45° field of view
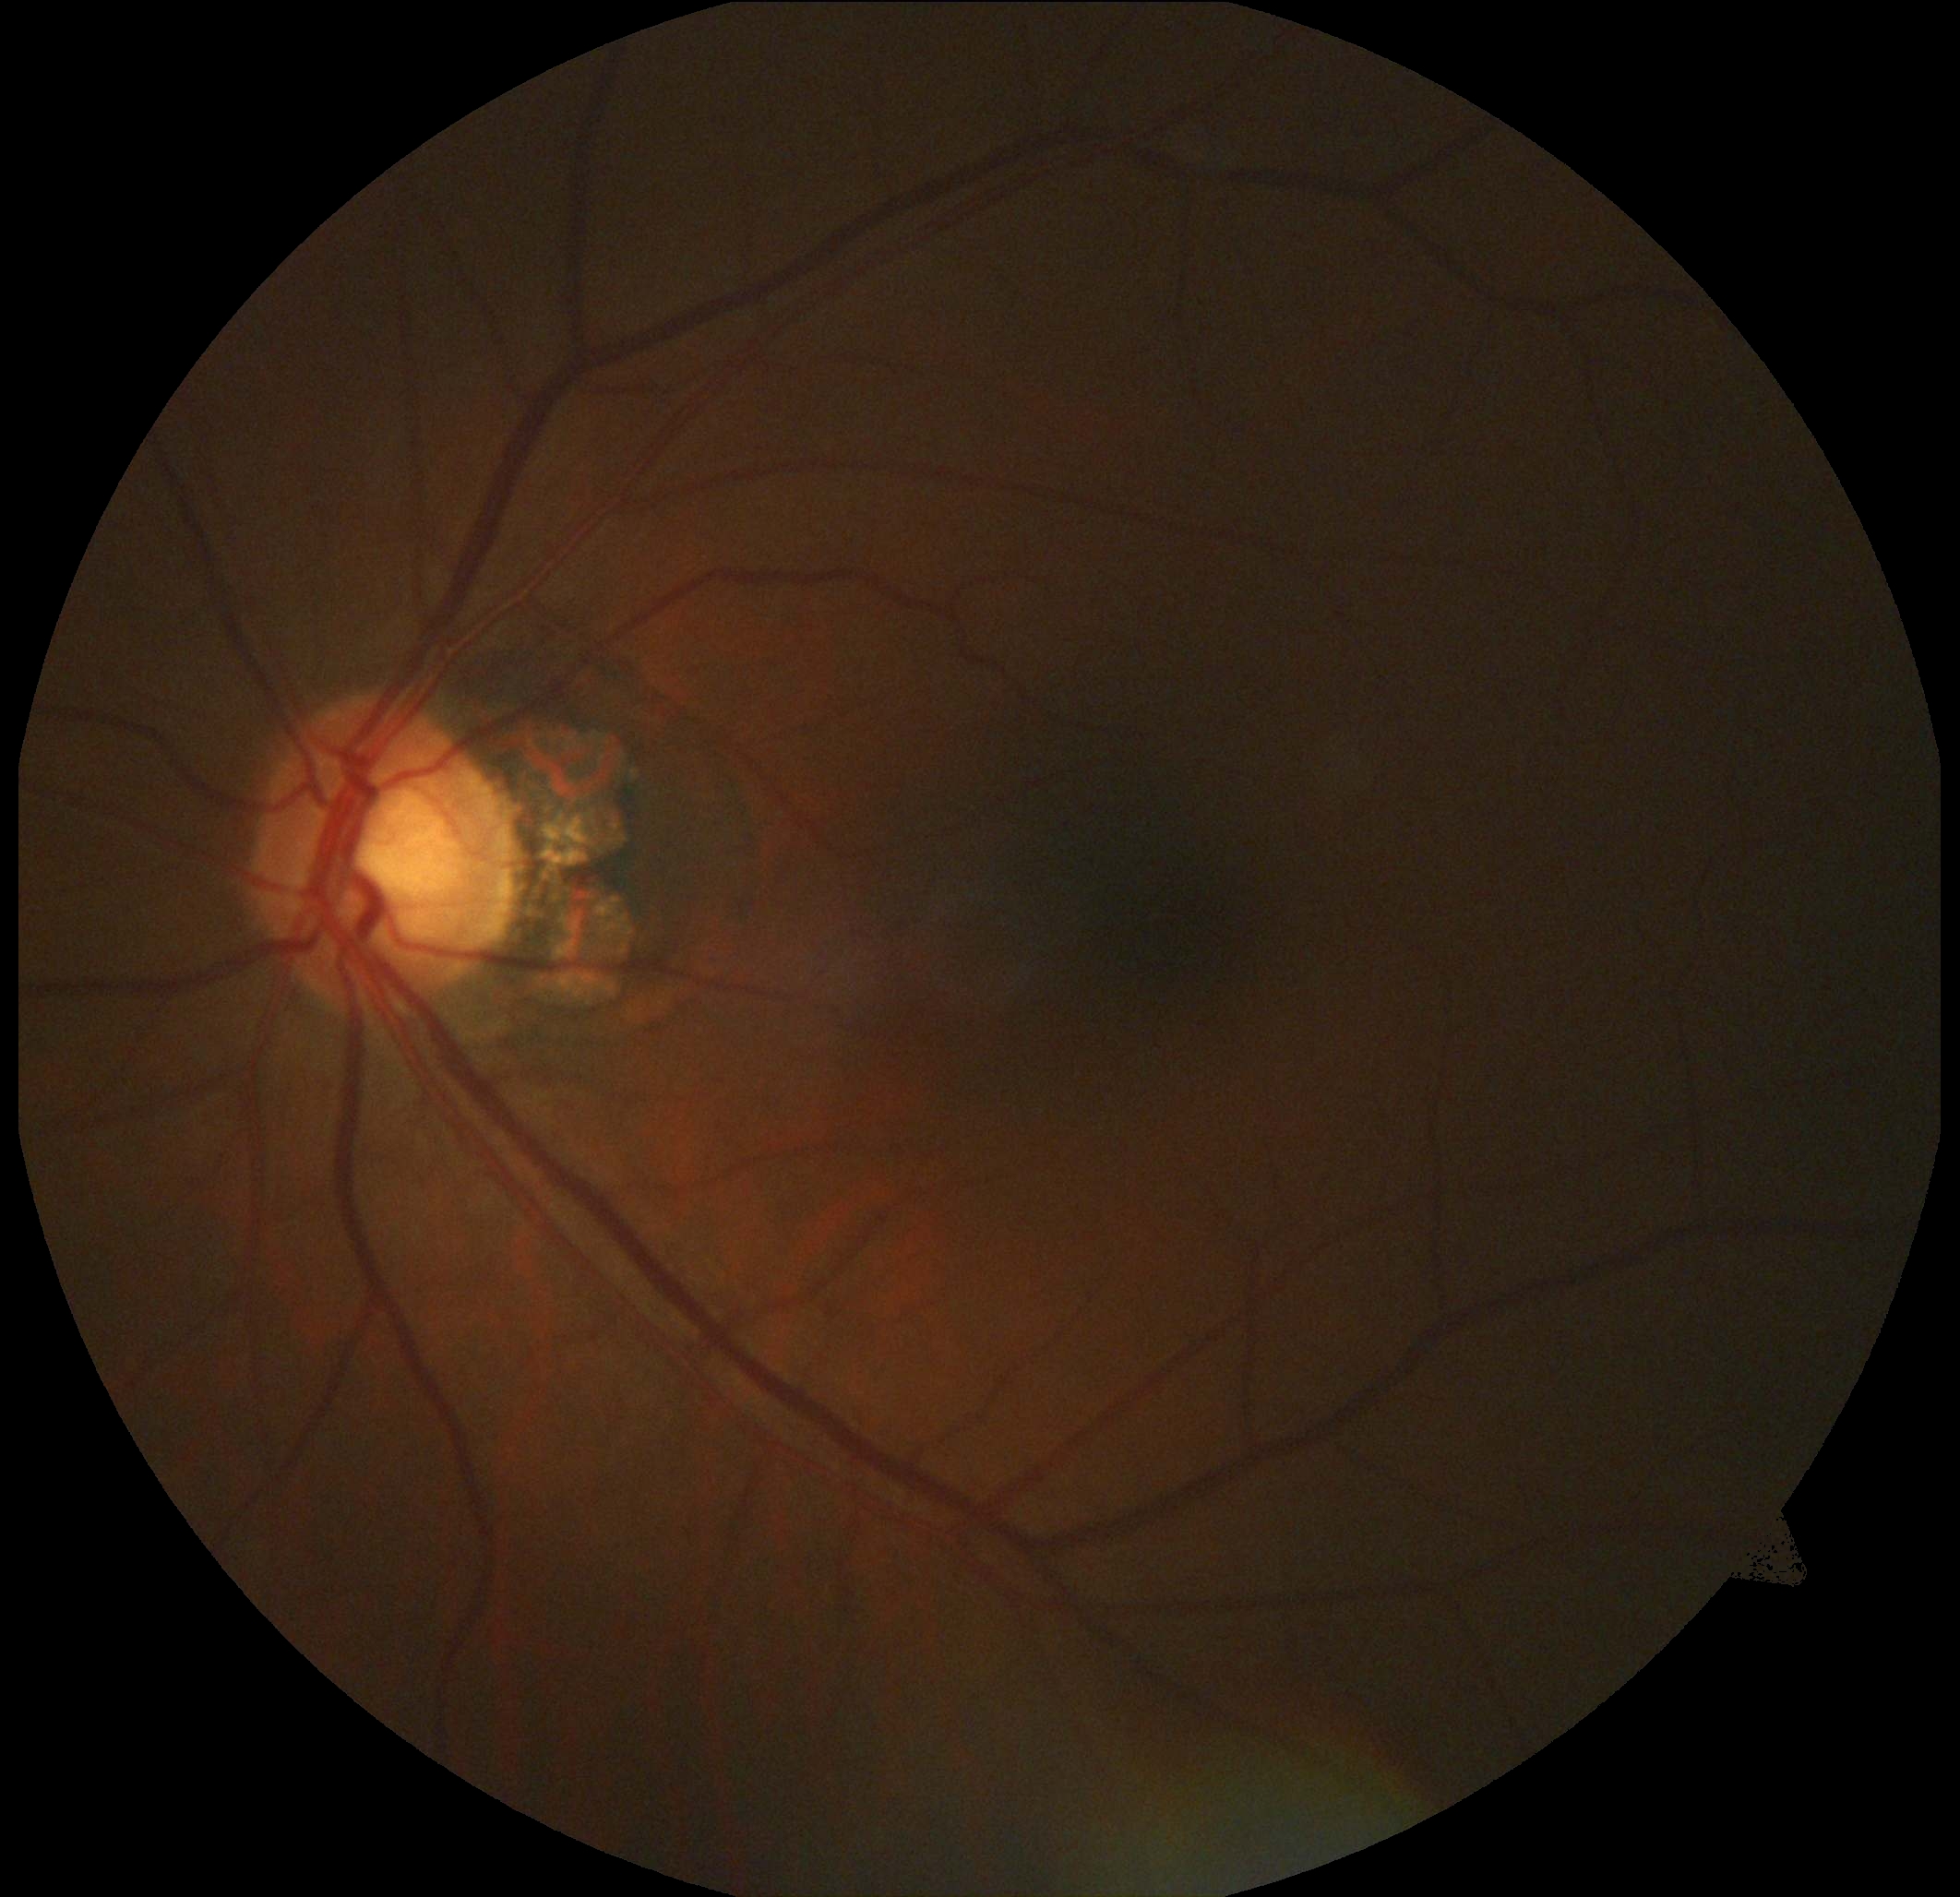 Retinopathy grade: 0 (no apparent retinopathy).